Nonmydriatic. FOV: 45 degrees. CFP. Image size 848x848: 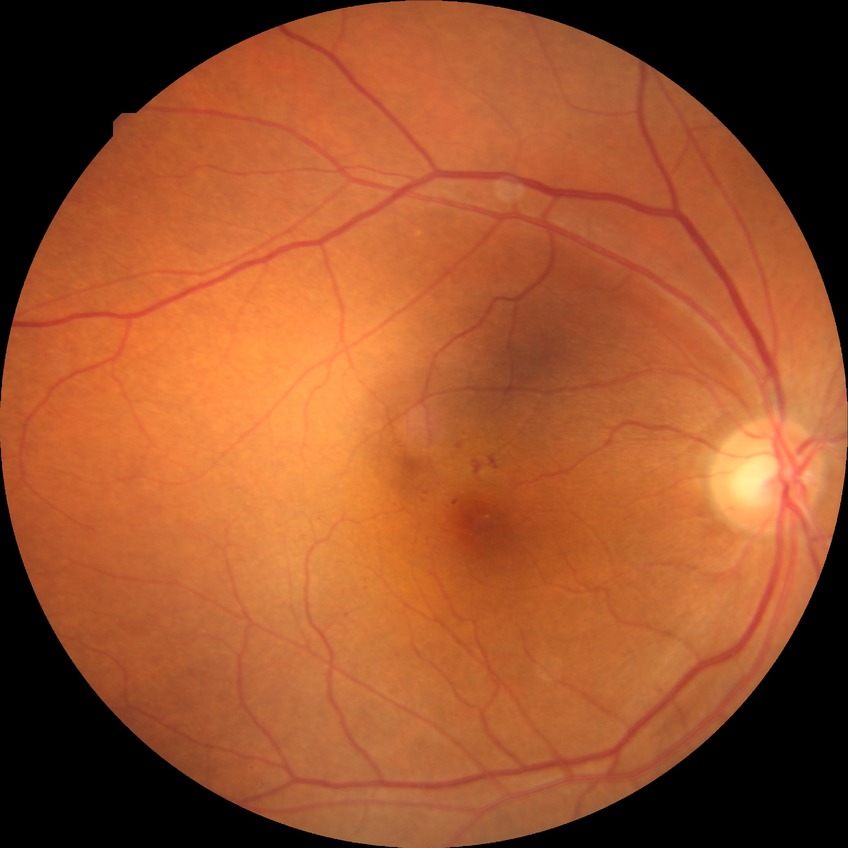
Annotations:
* diabetic retinopathy (DR) — simple diabetic retinopathy (SDR)